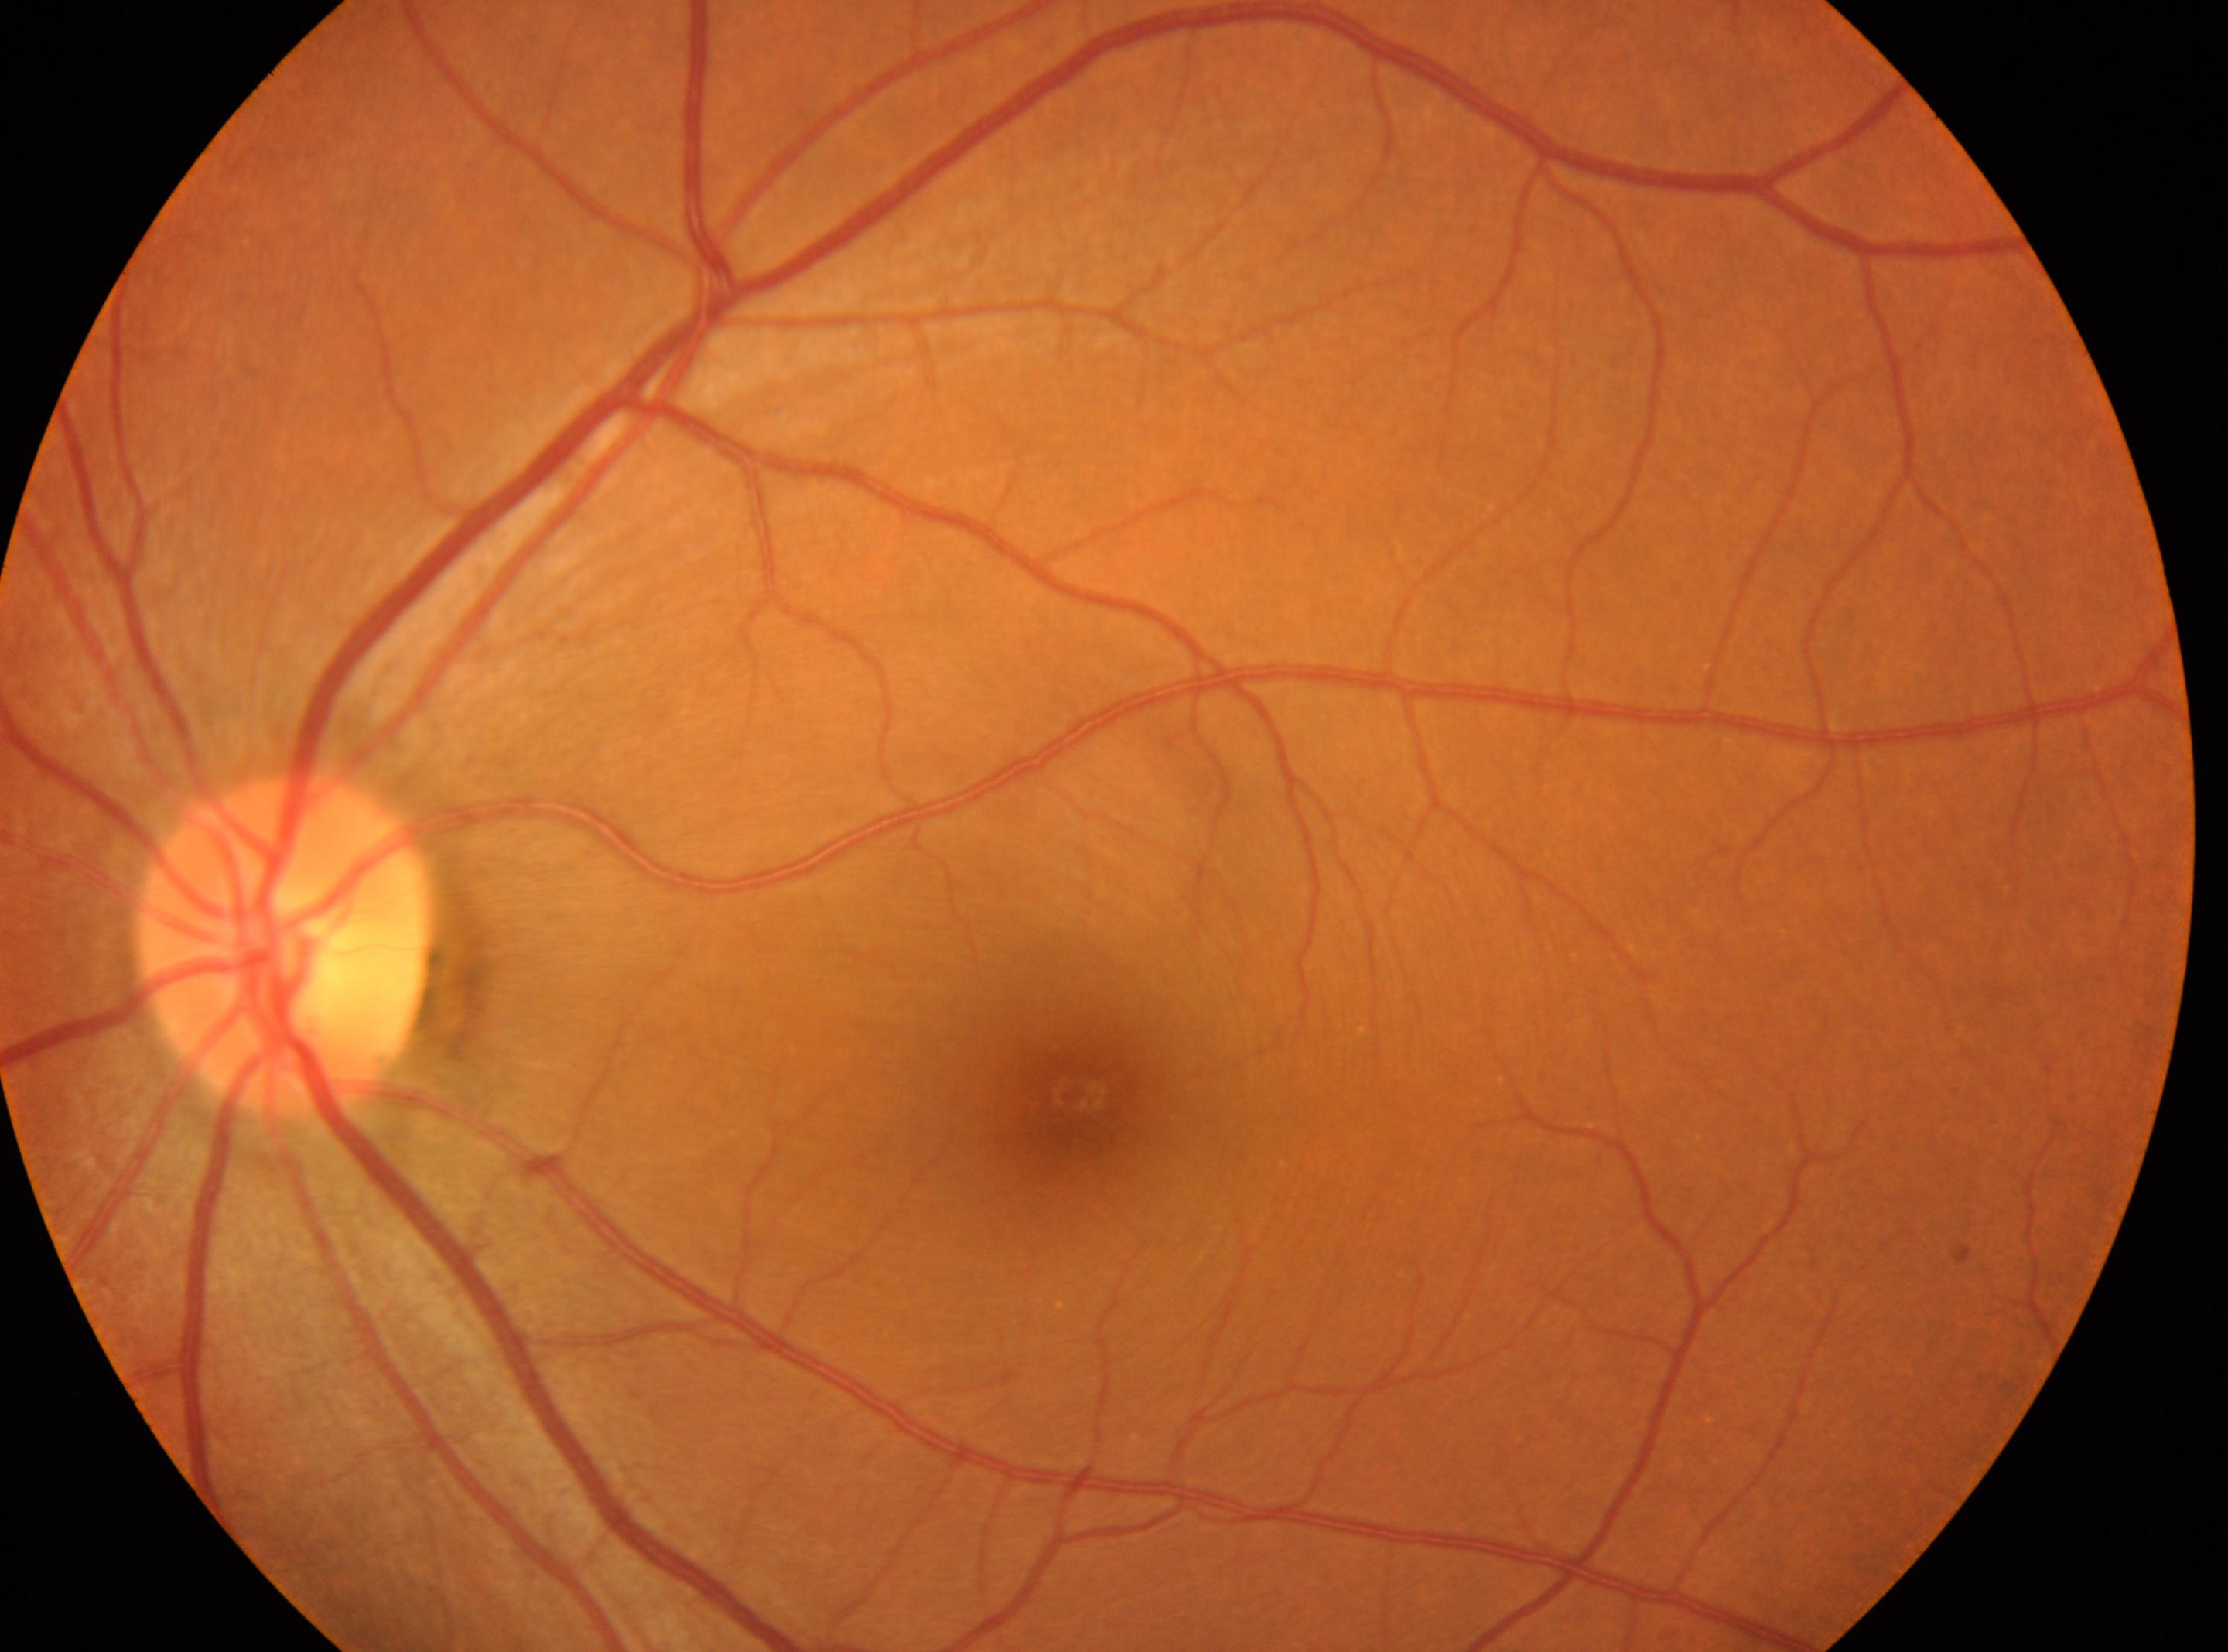 The image shows the left eye. DR grade: no apparent diabetic retinopathy (0). No apparent diabetic retinopathy. Macular center located at [1072, 1094]. Optic nerve head located at [285, 947].